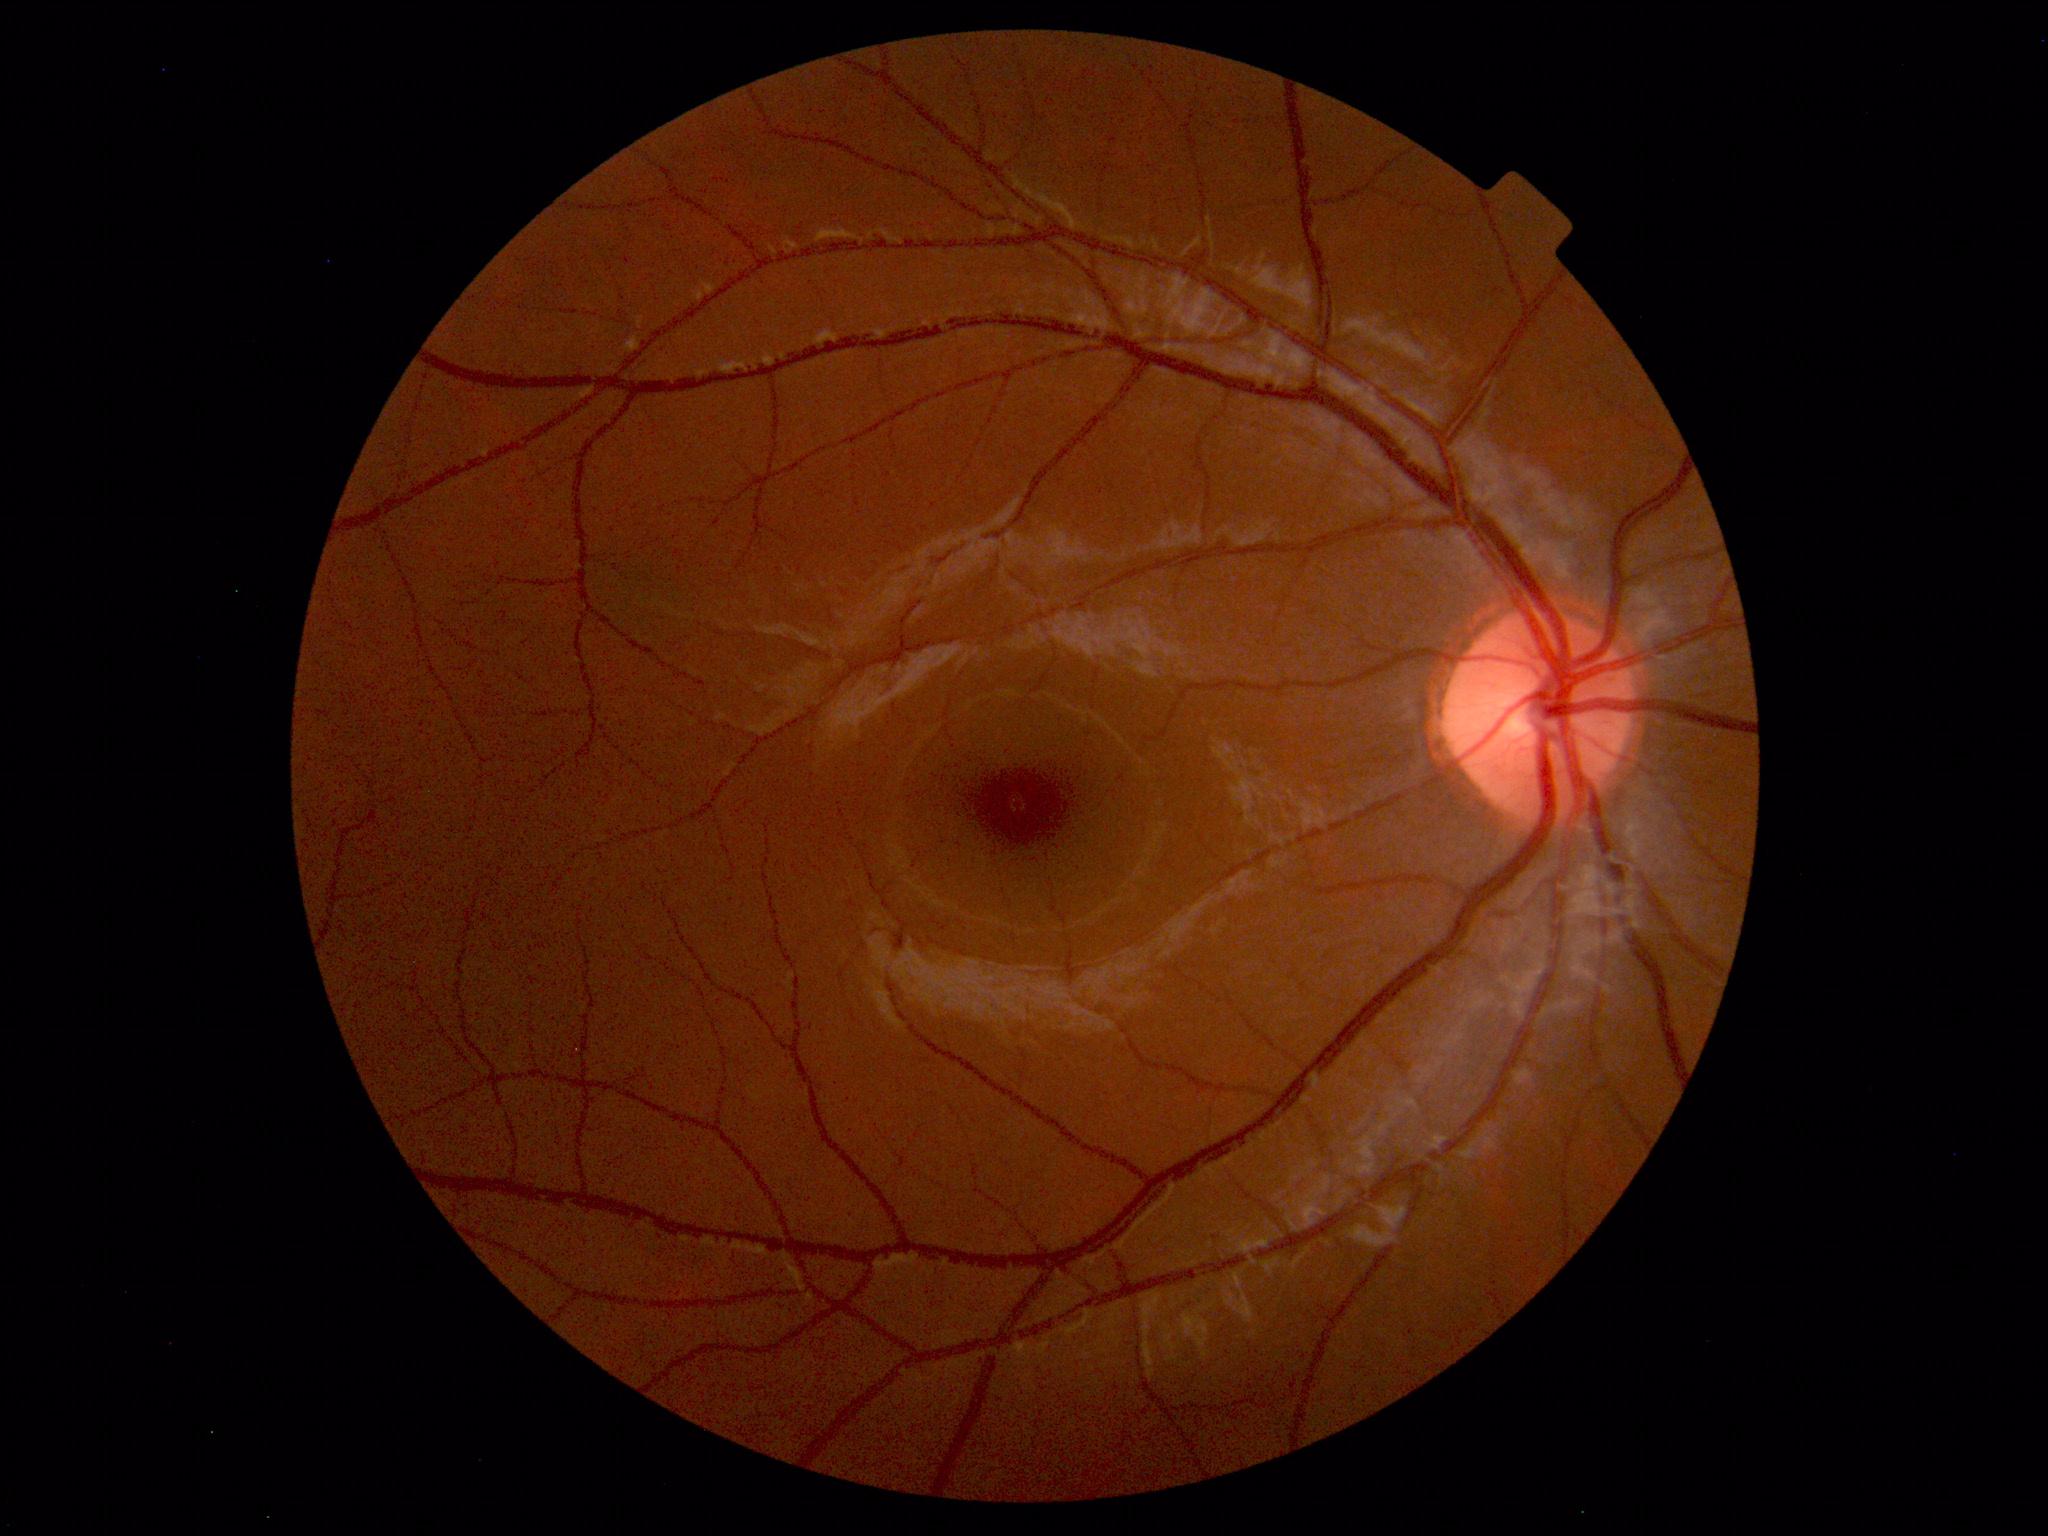
Normal fundus appearance.